Fundus photo; 848 by 848 pixels; NIDEK AFC-230
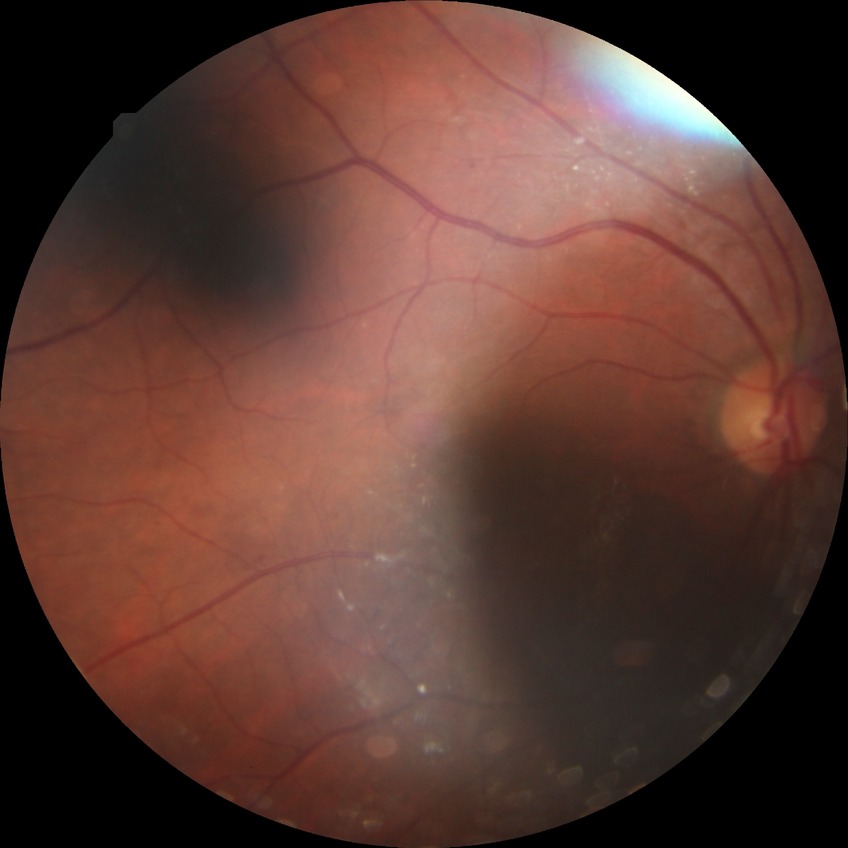   davis_grade: SDR